Modified Davis classification.
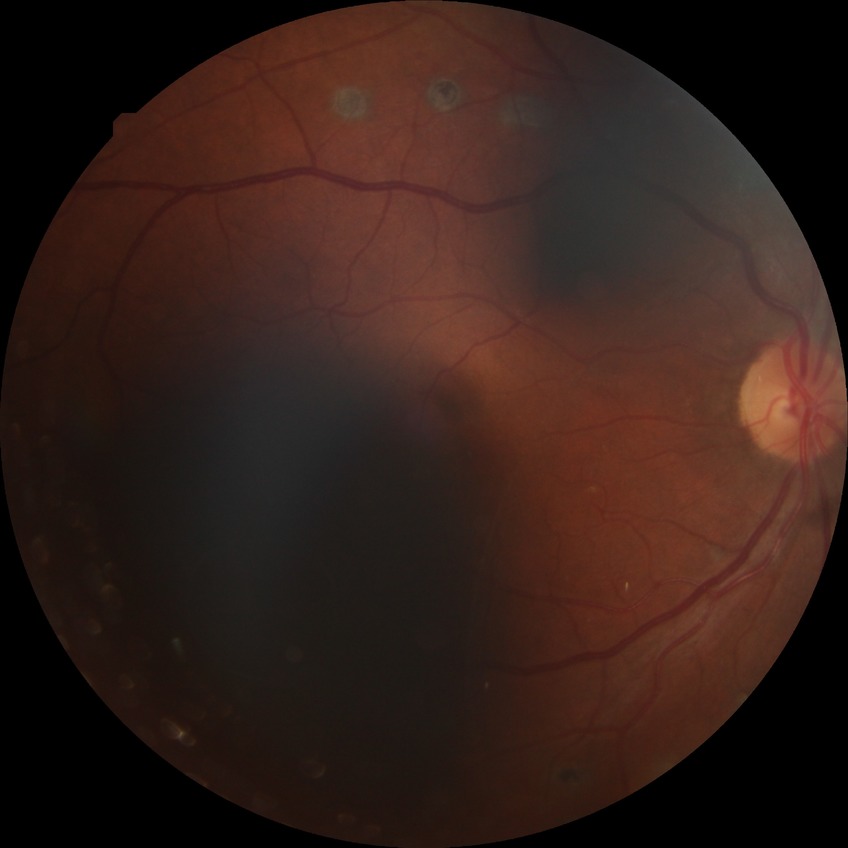 Diabetic retinopathy (DR) is PDR (proliferative diabetic retinopathy).